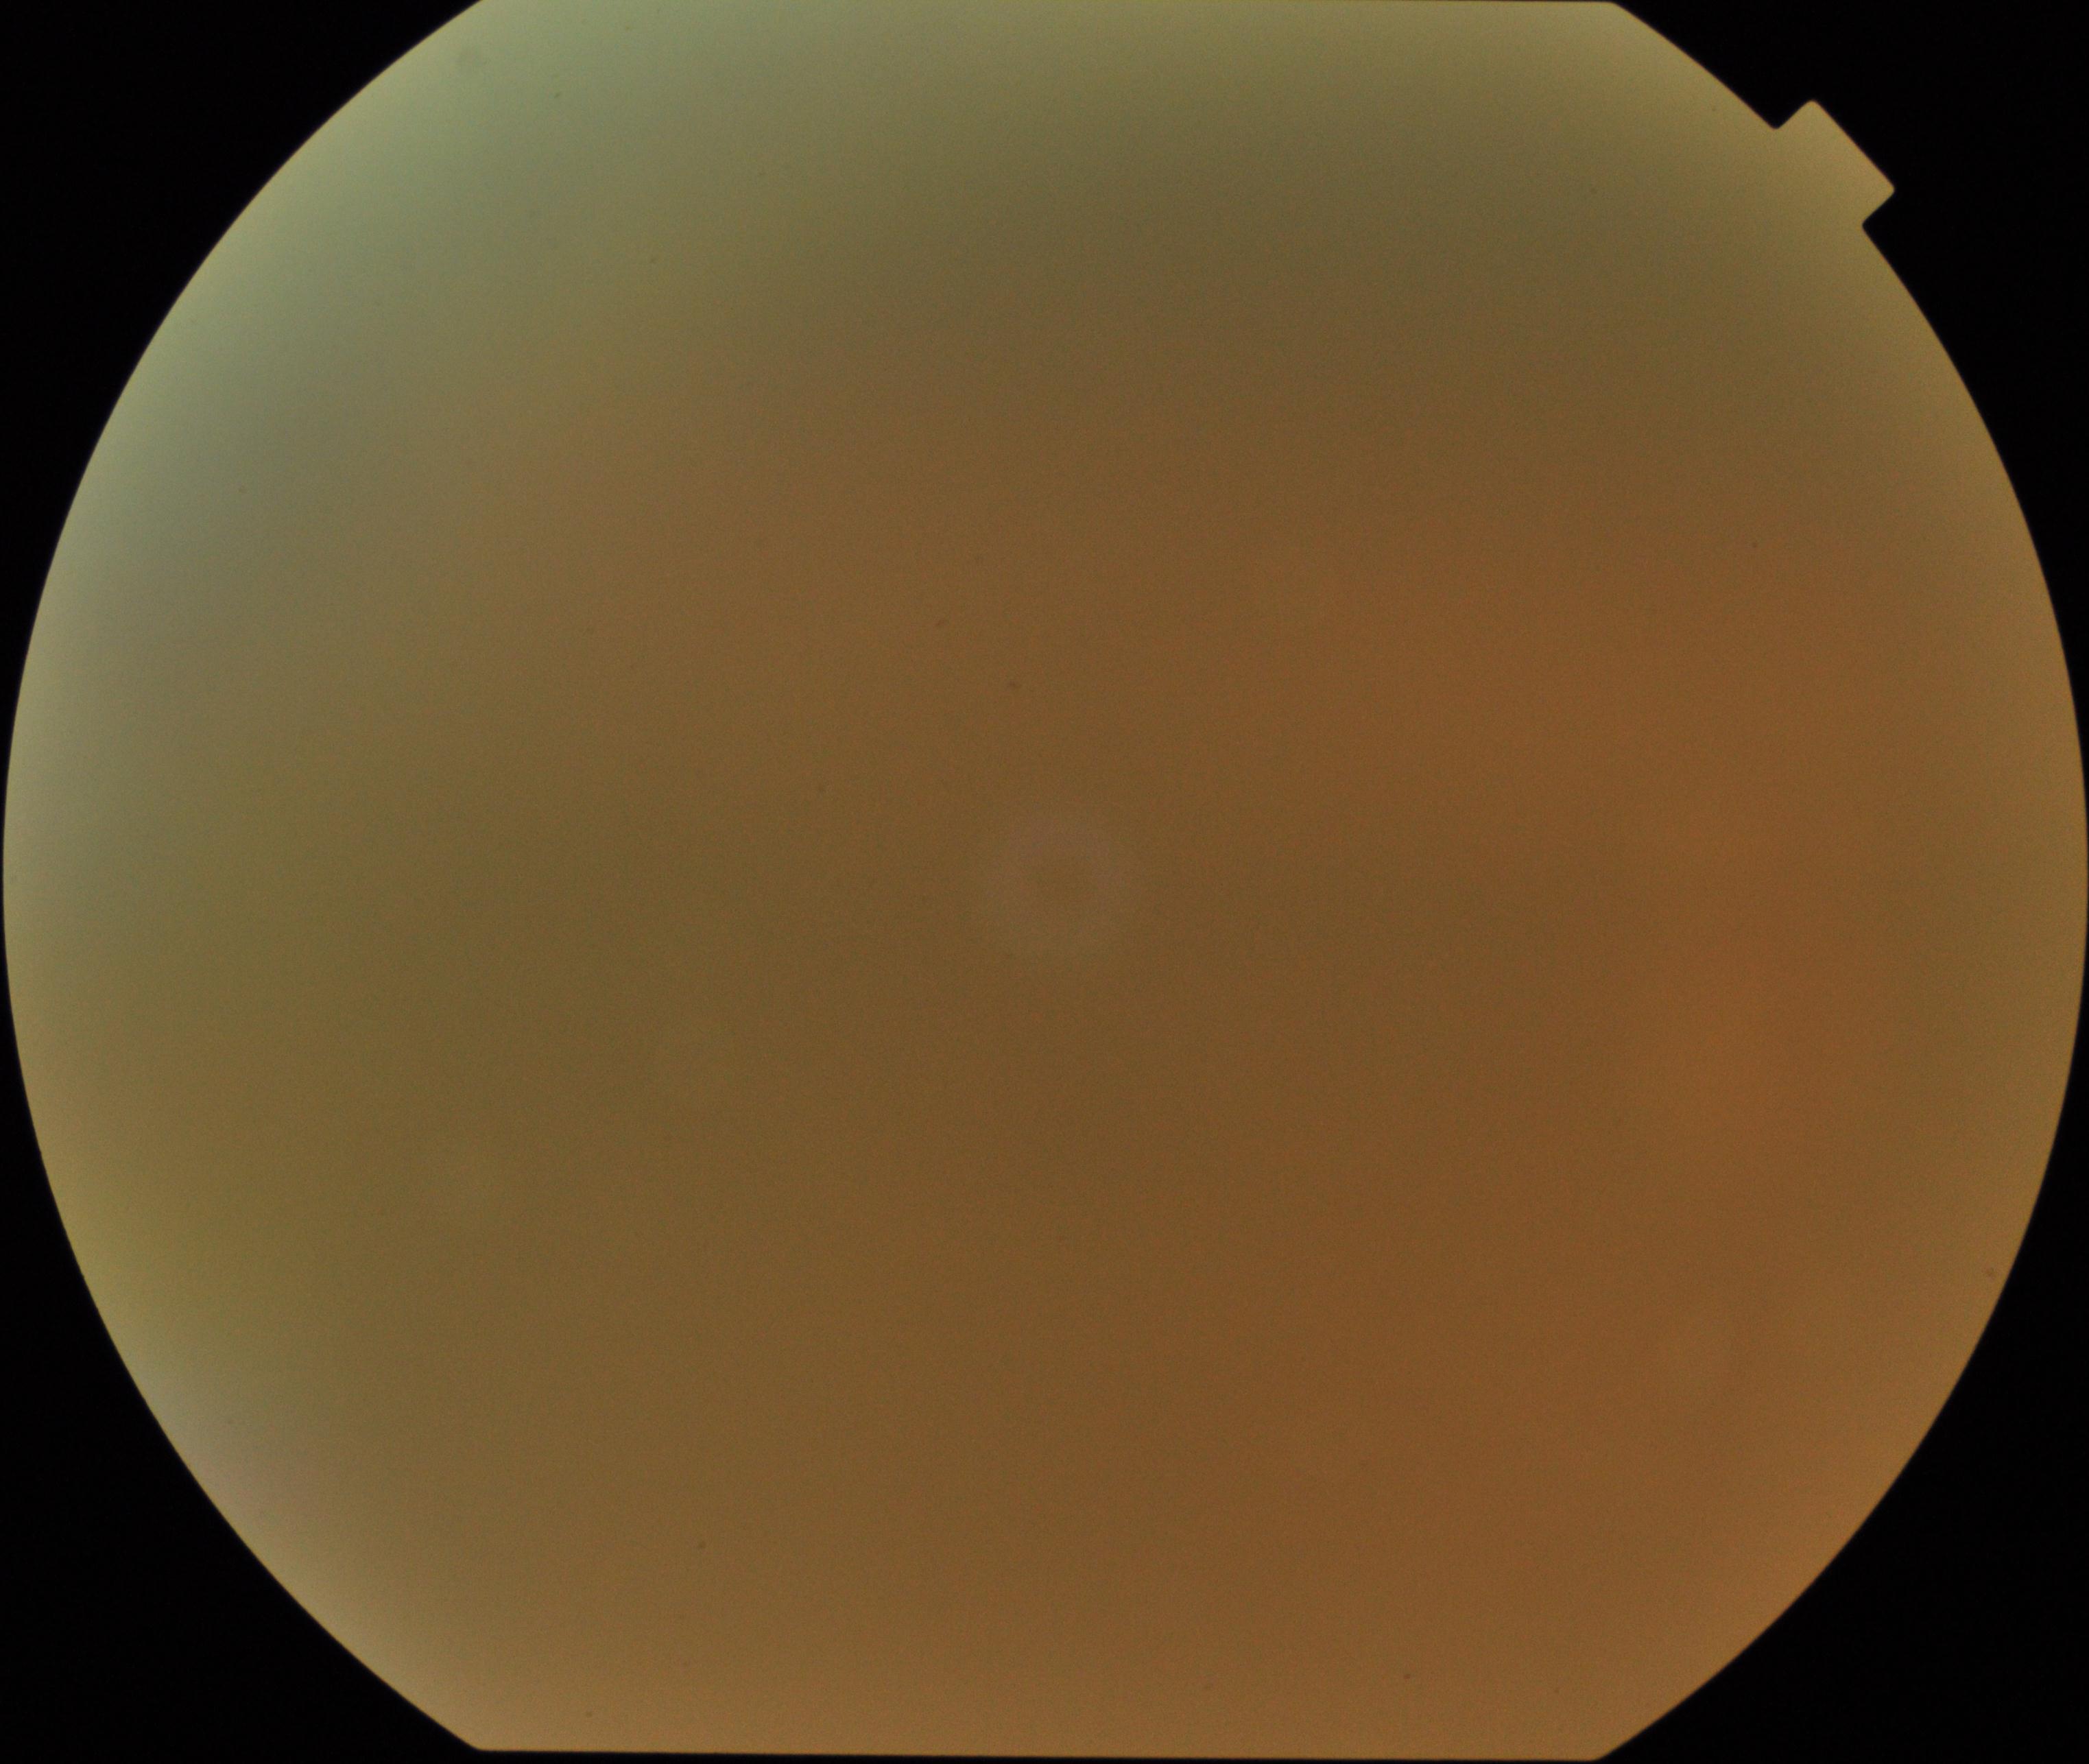
Blurred fundus image with substantial obscuration of retinal landmarks. Proliferative diabetic retinopathy not identified in the visible portion.